45-degree field of view; acquired with a NIDEK AFC-230:
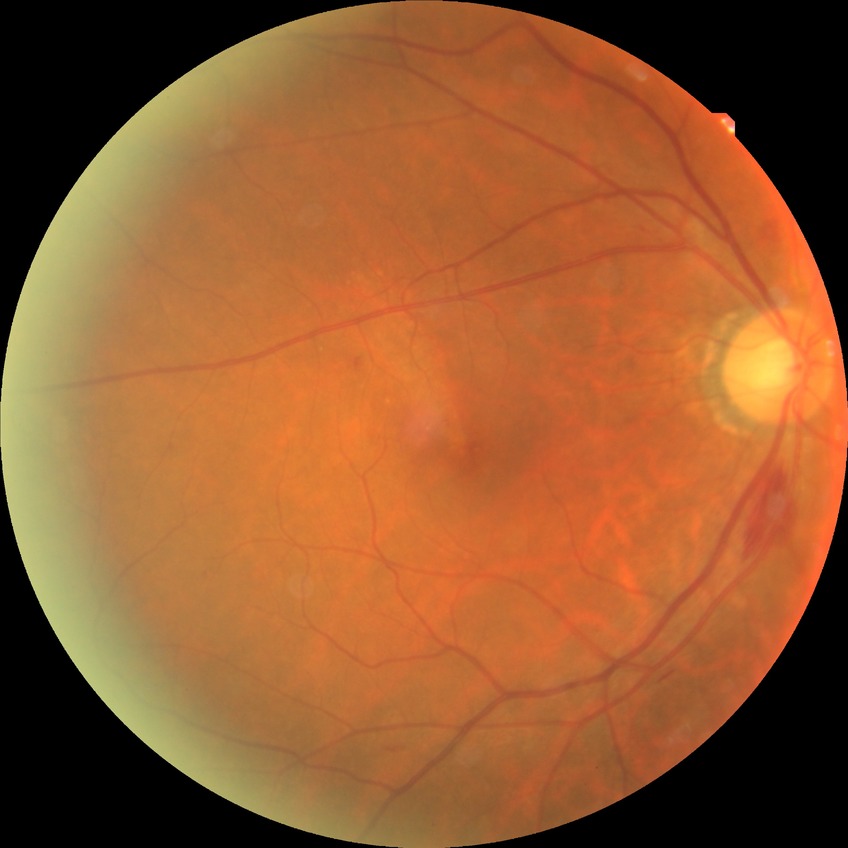

Diabetic retinopathy (DR) is simple diabetic retinopathy (SDR).